Color fundus photograph: 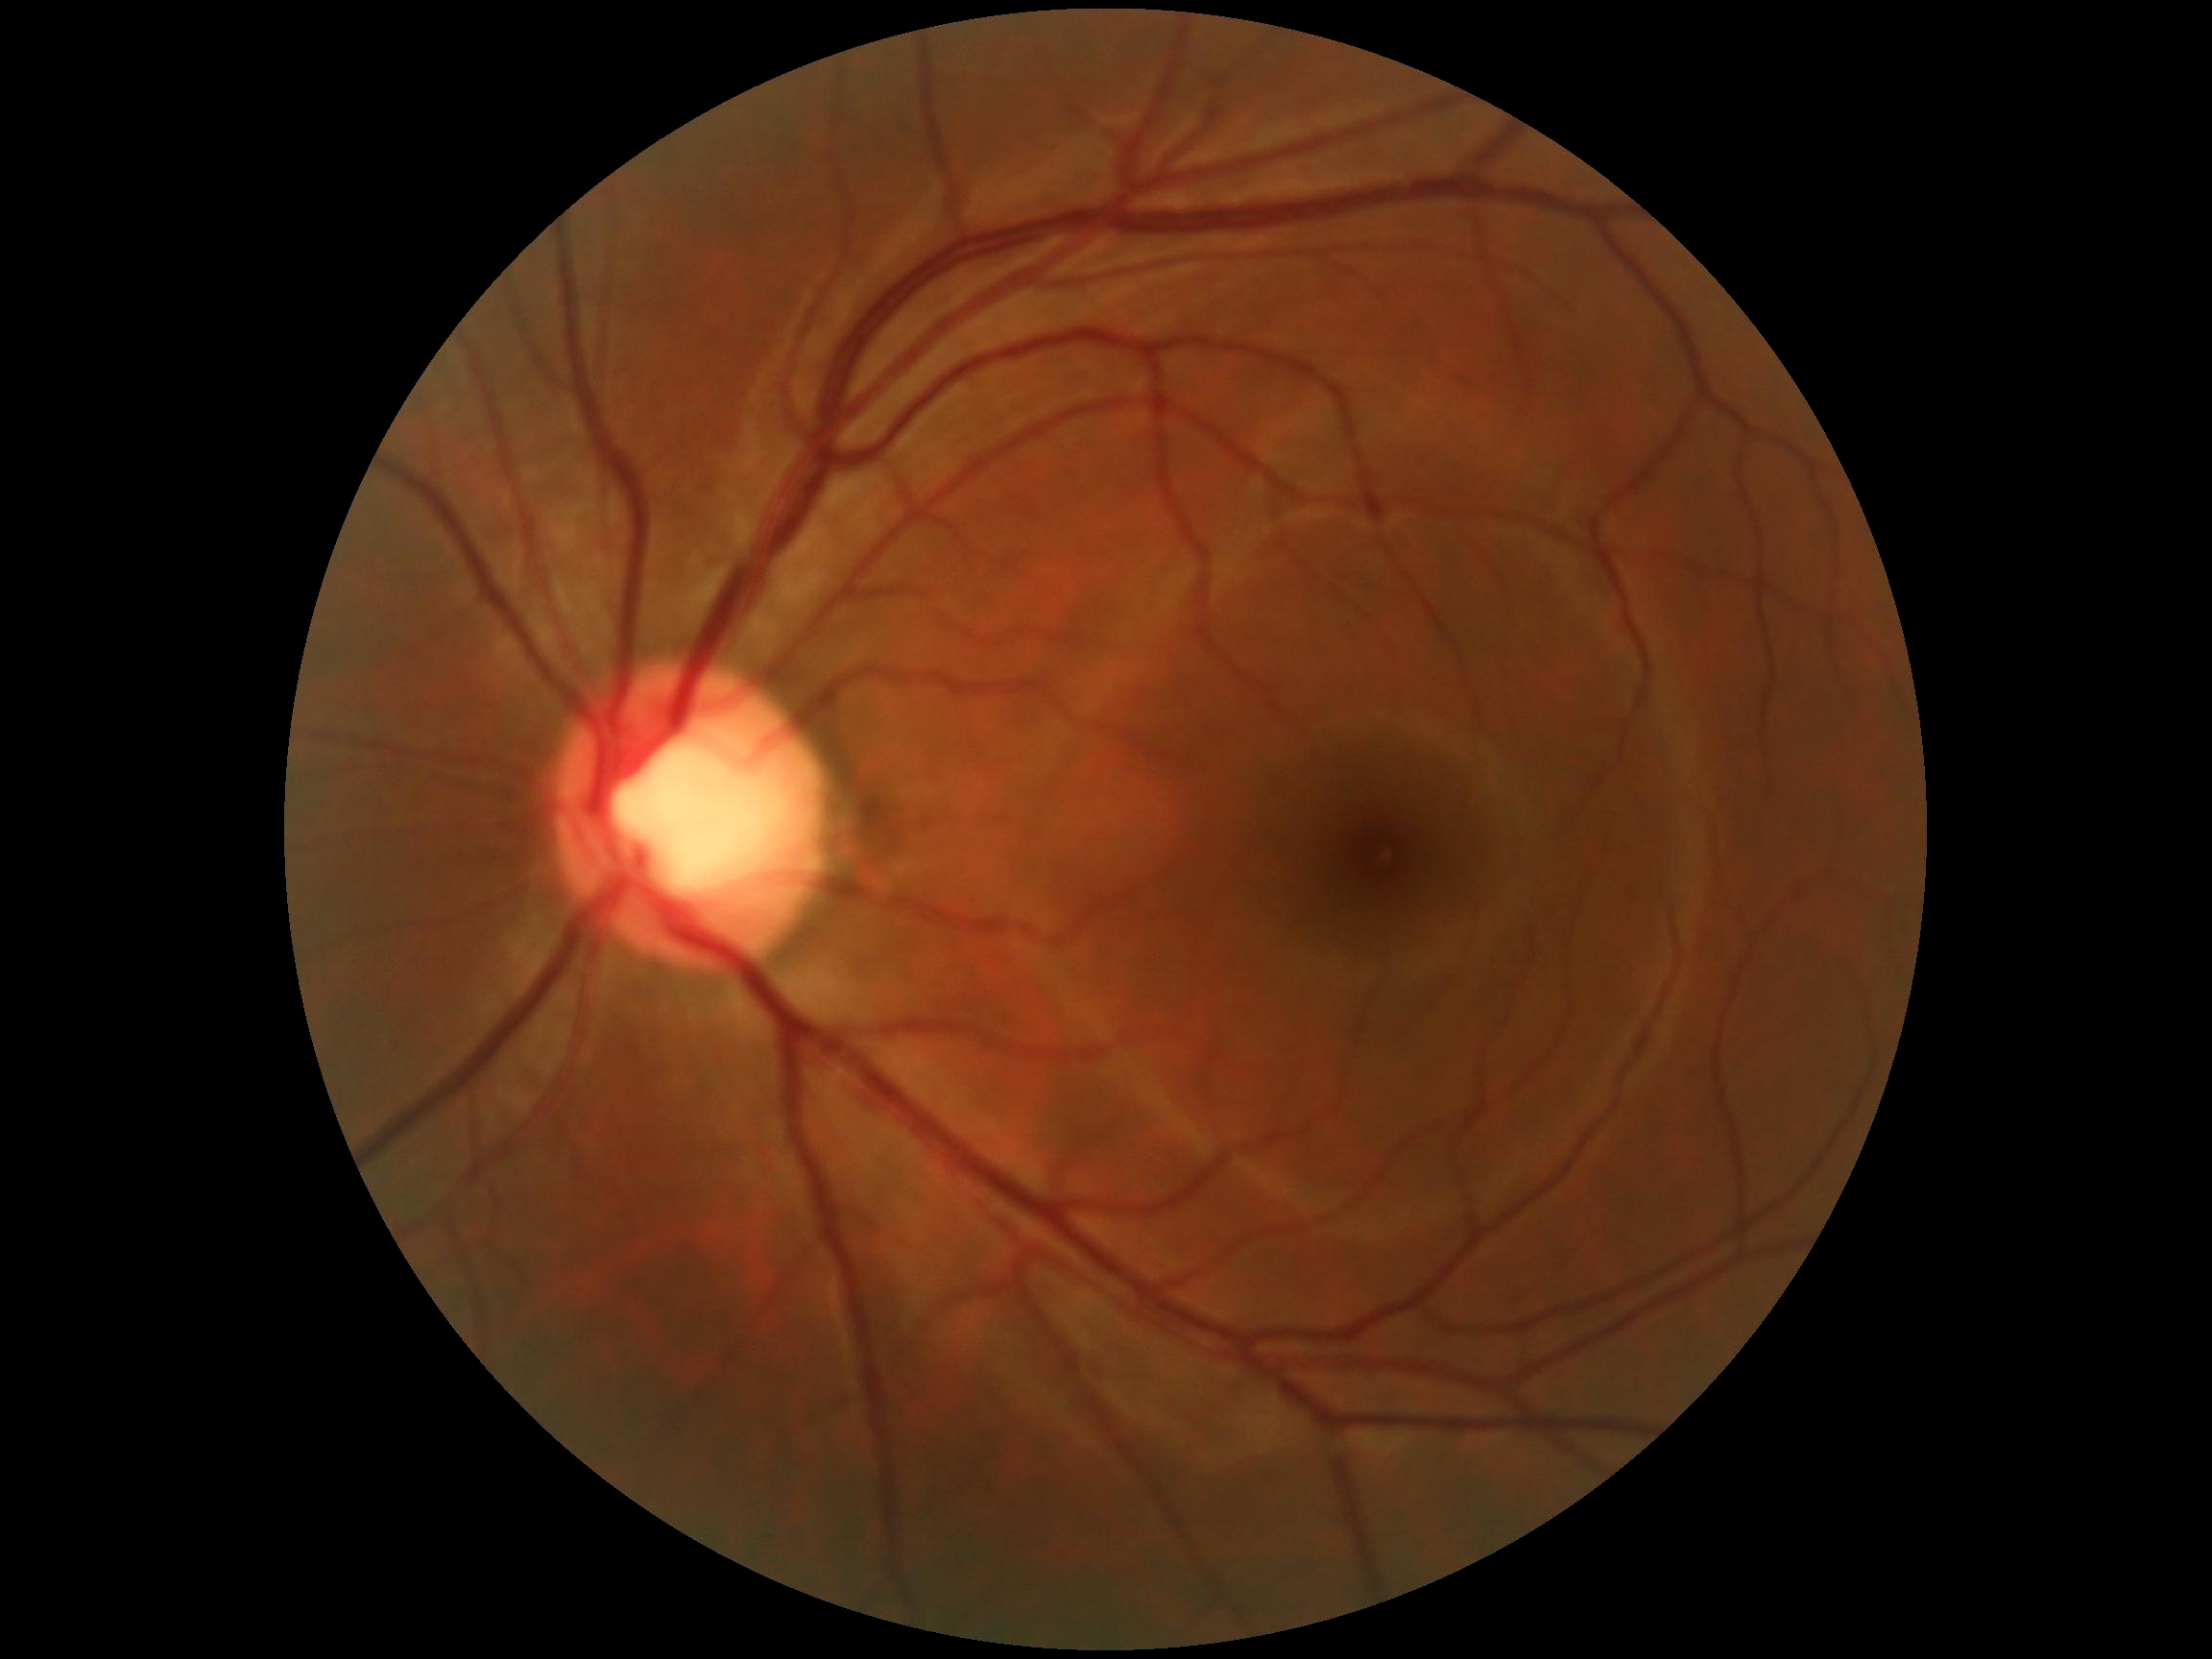

{
  "dr_grade": "grade 0 (no apparent retinopathy)"
}